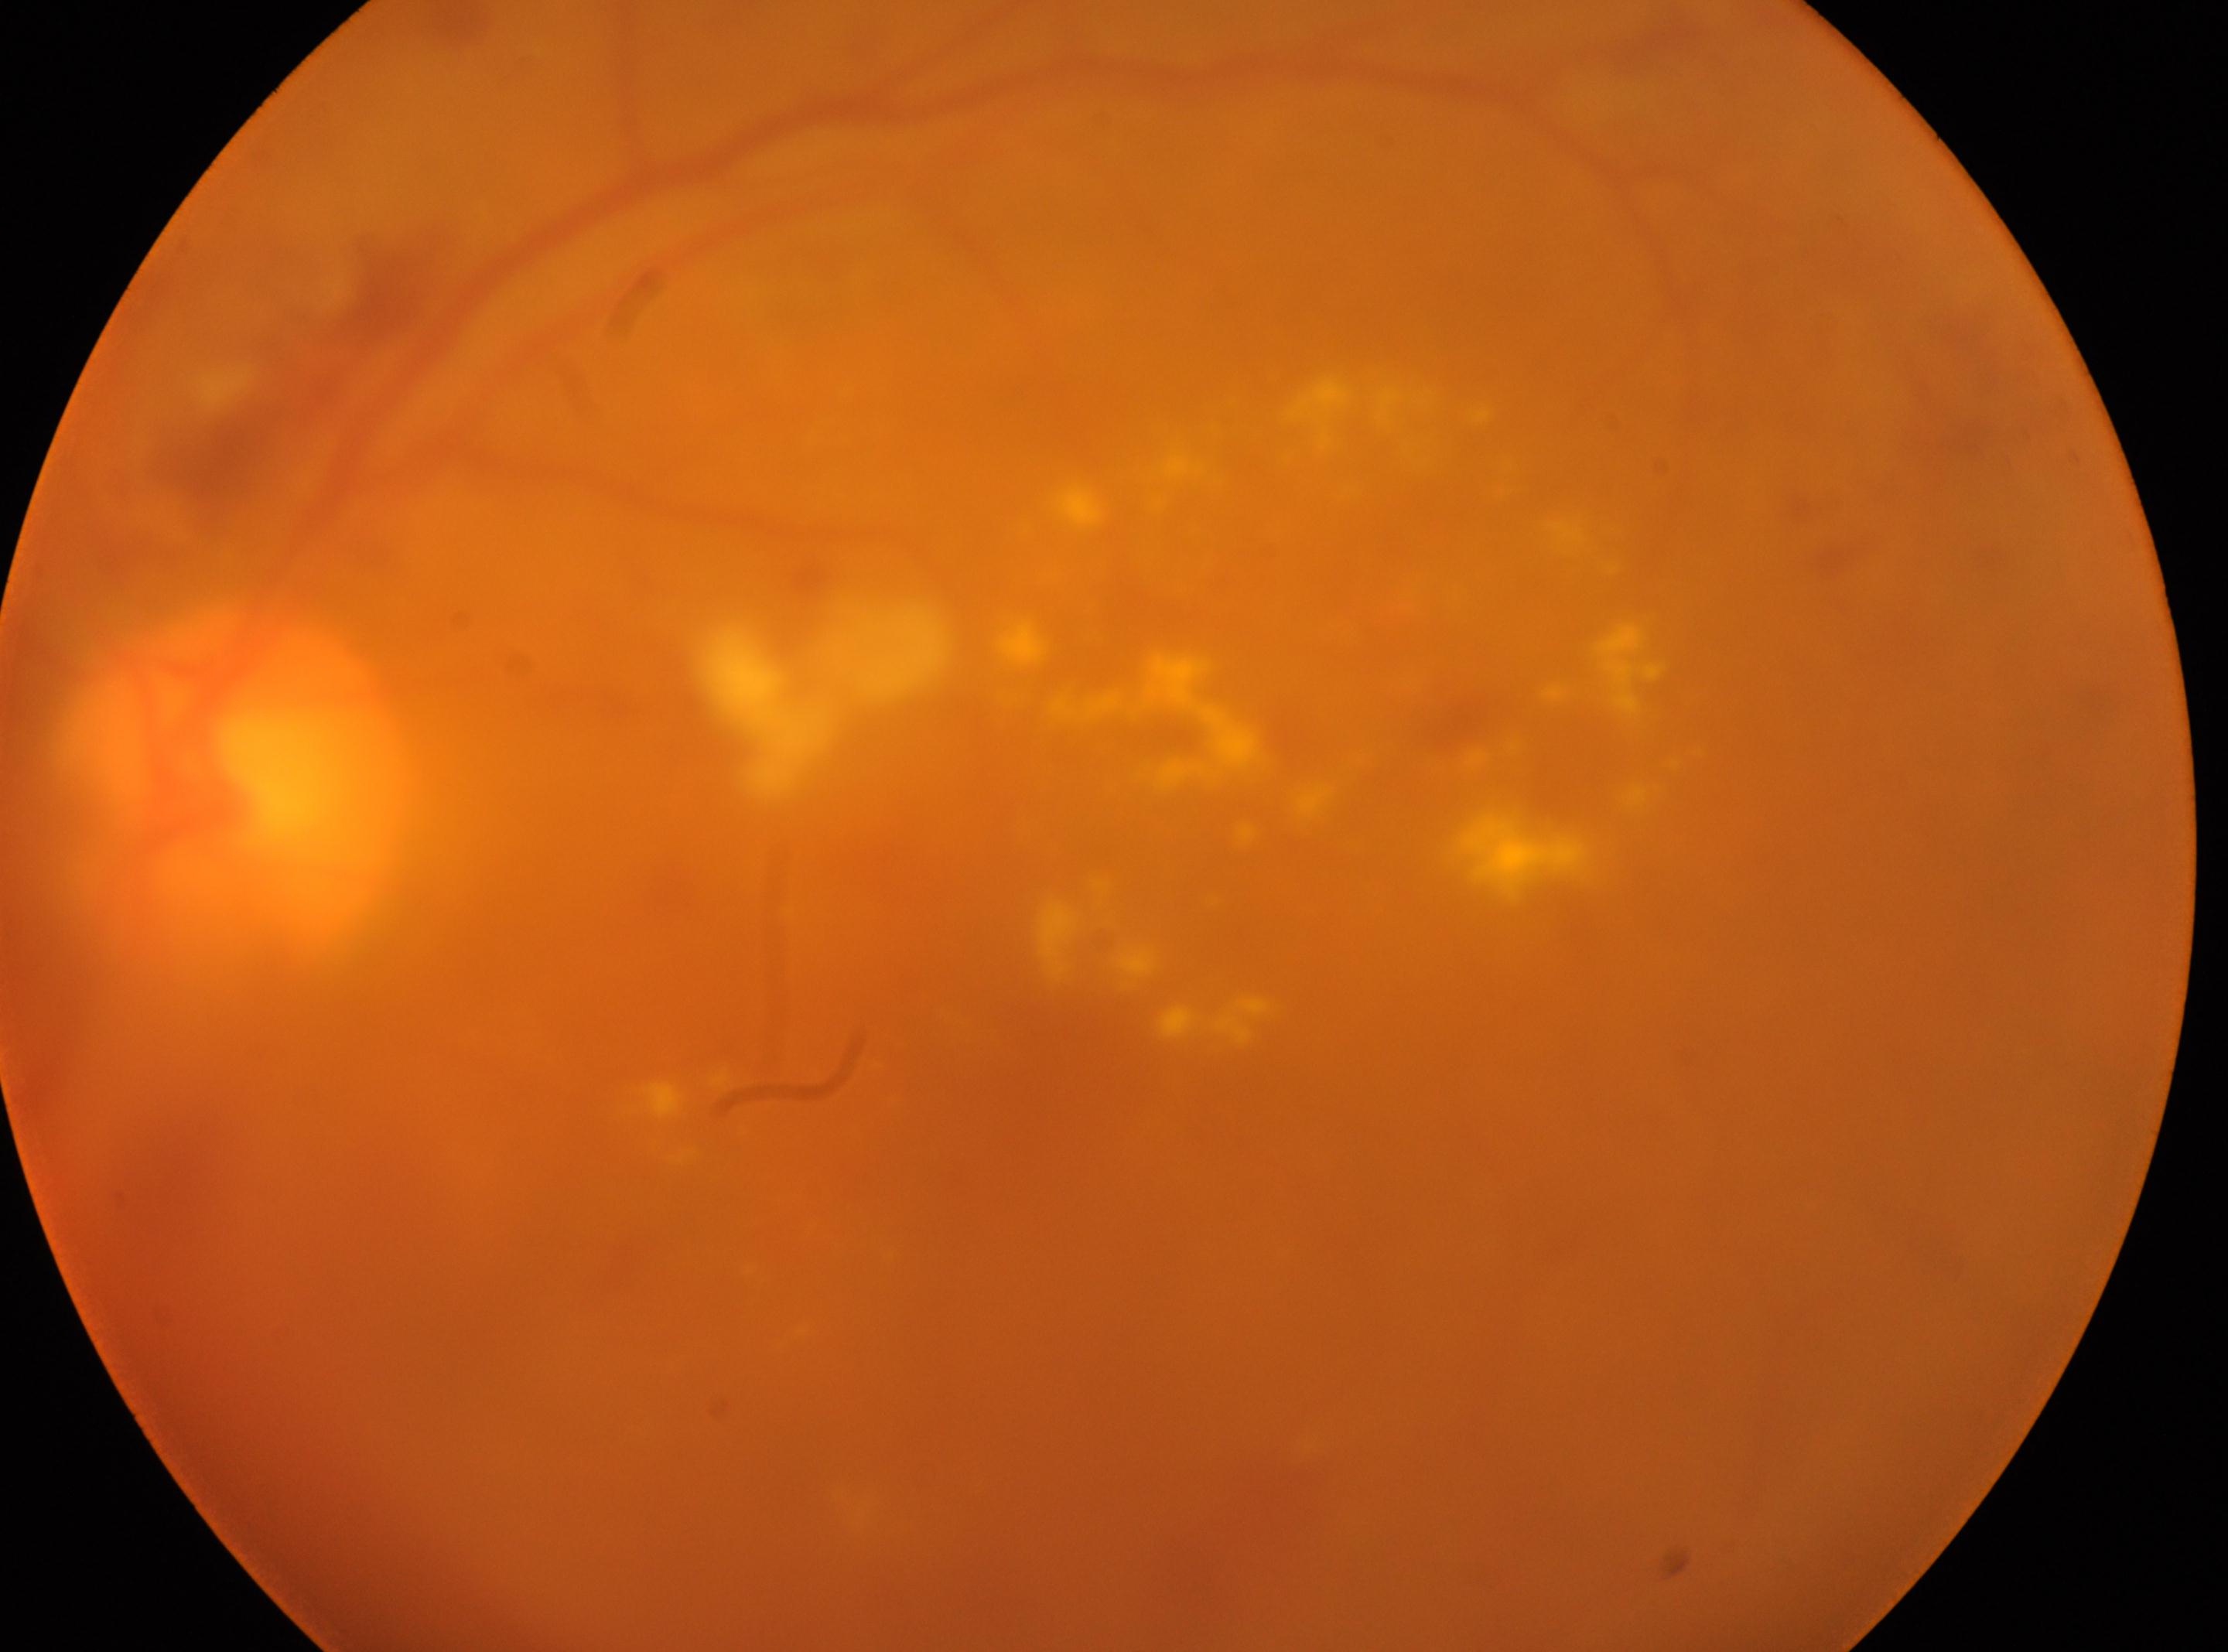

fovea: 1108px, 1016px | DR severity: 4 | disc center: 240px, 786px | the left eye.